No pharmacologic dilation; camera: NIDEK AFC-230; posterior pole photograph; image size 848x848; 45° field of view: 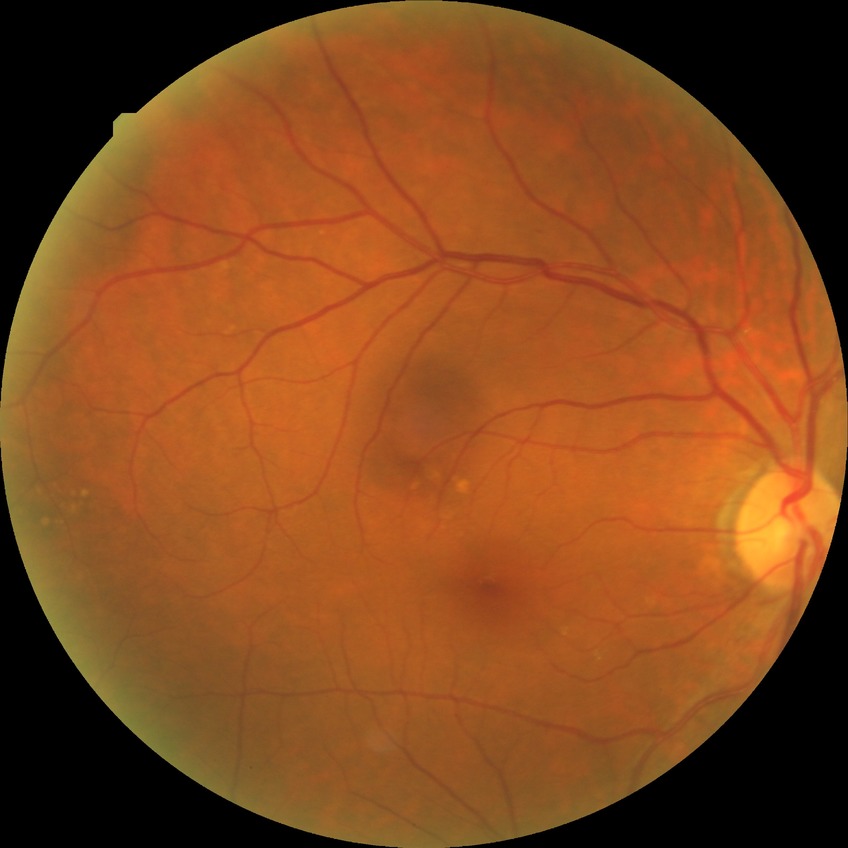
Retinopathy grade is no diabetic retinopathy.